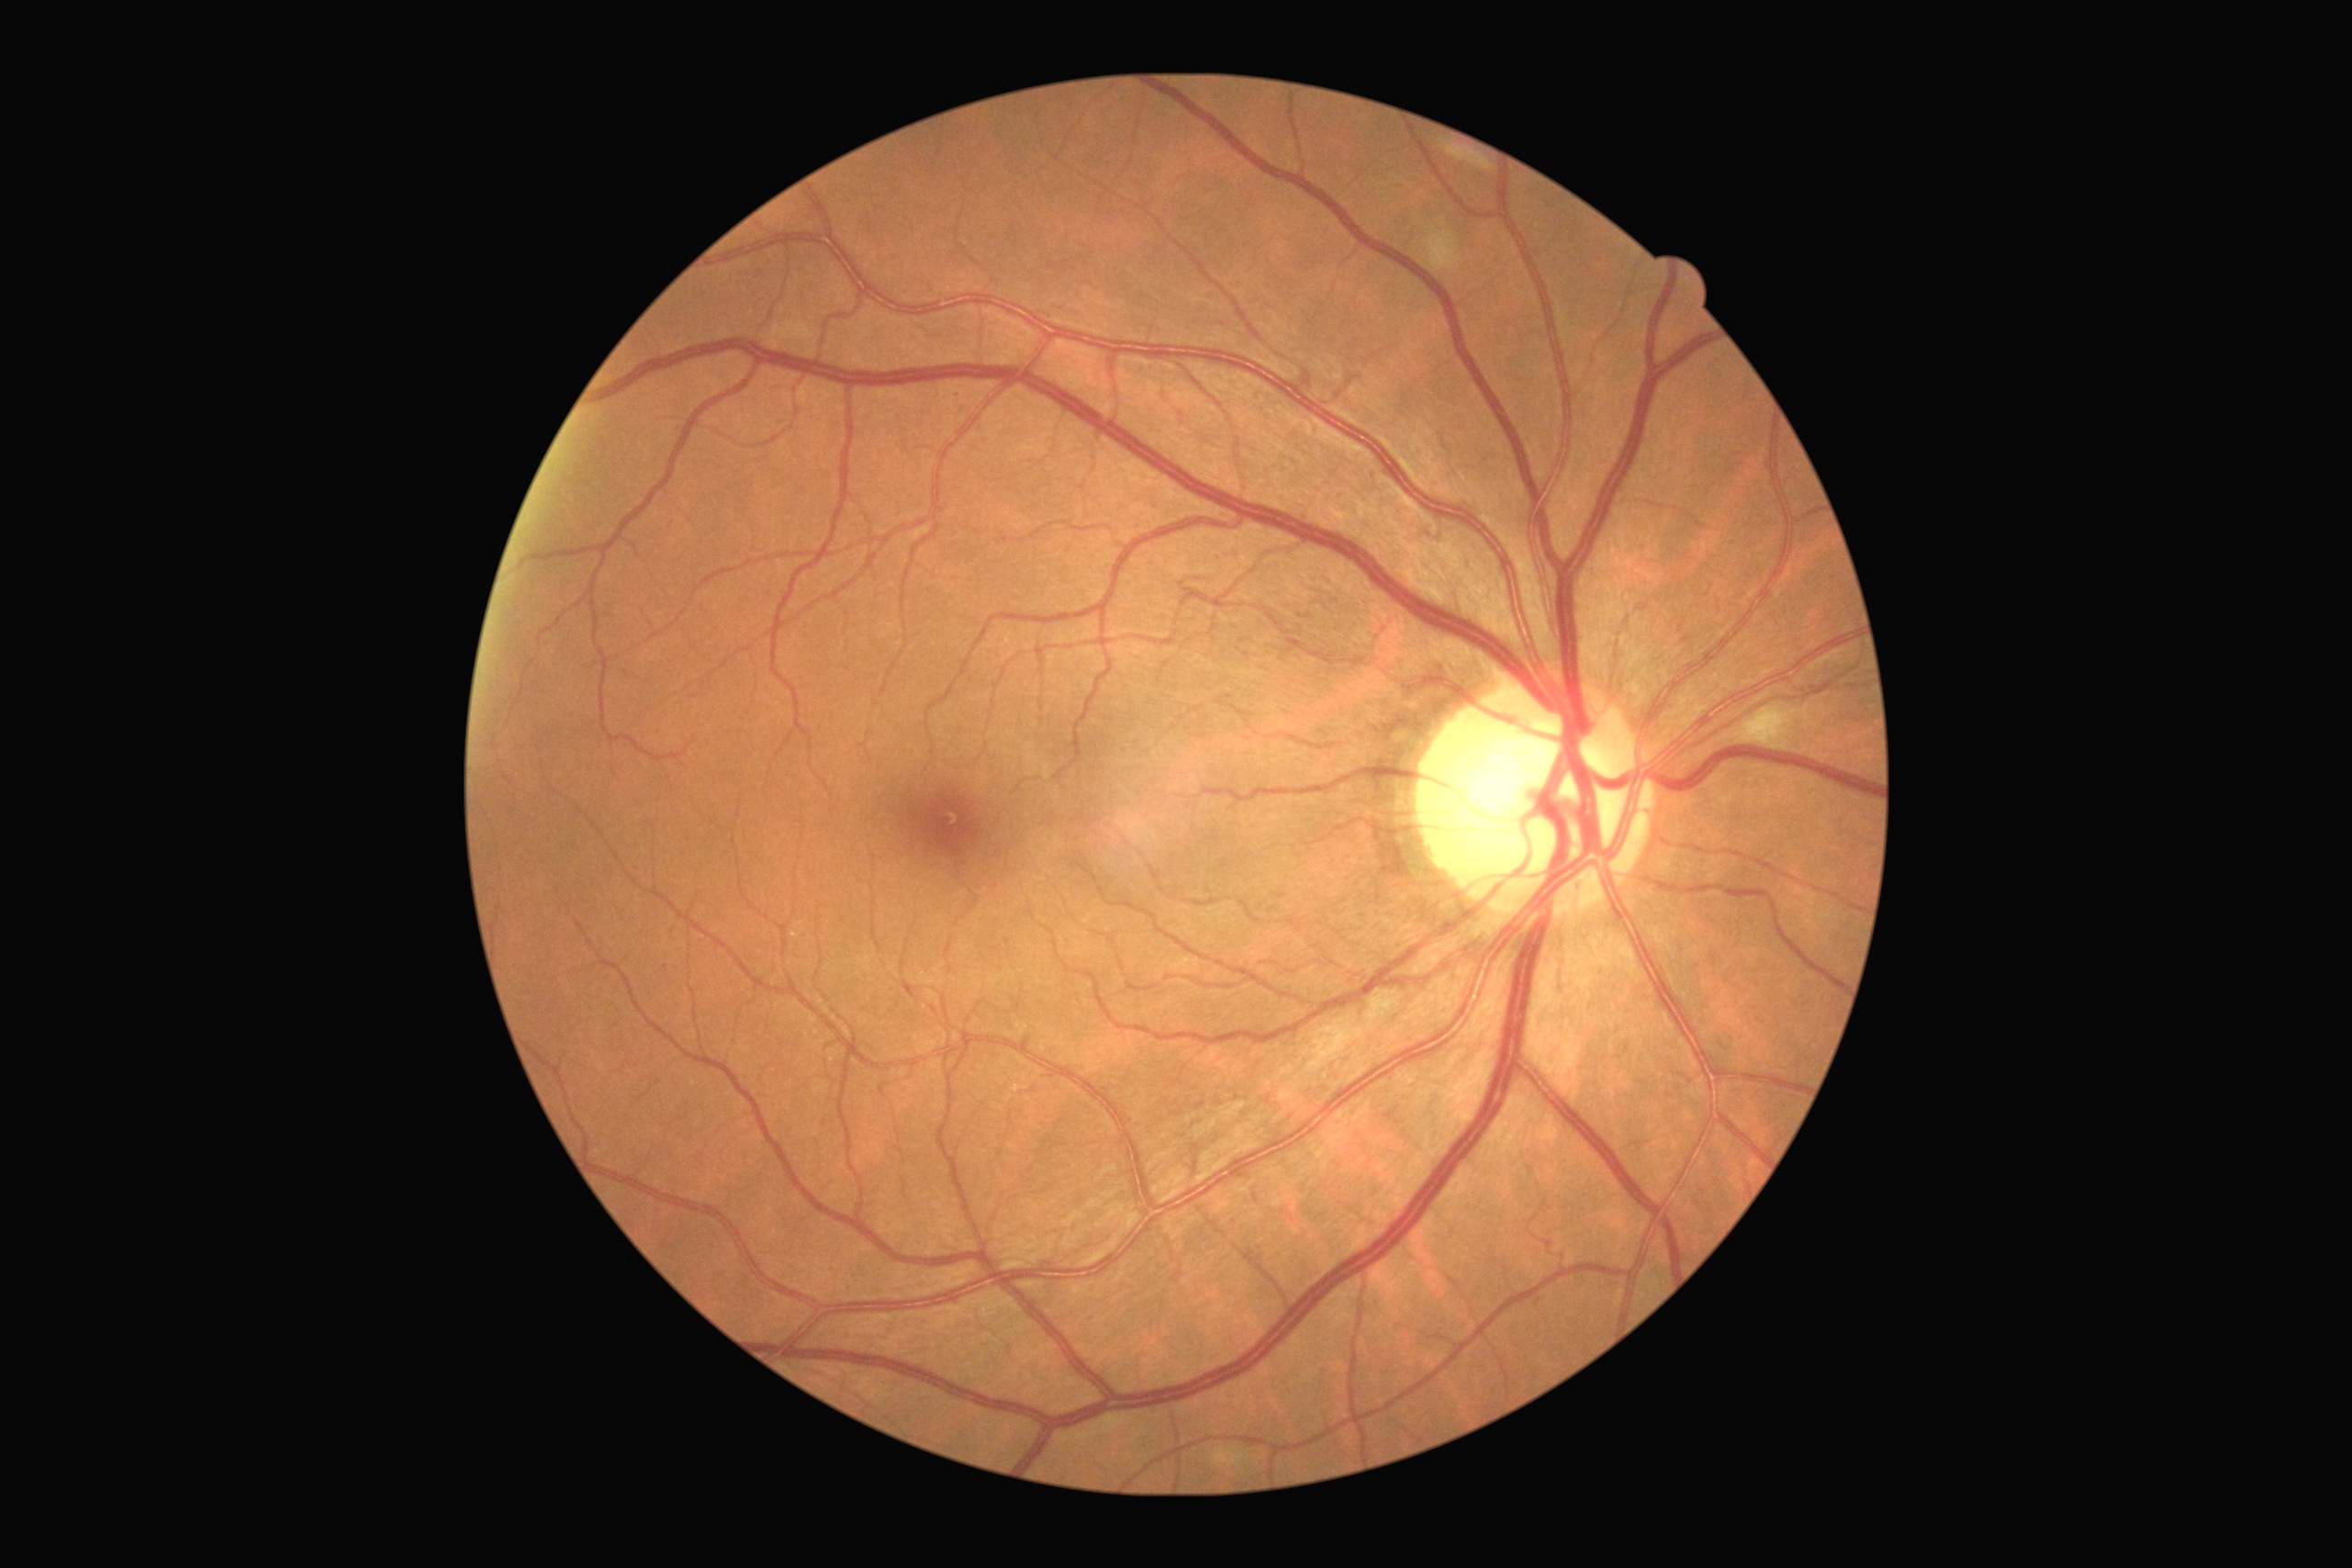 DR stage: 2.